2048 x 1536 pixels.
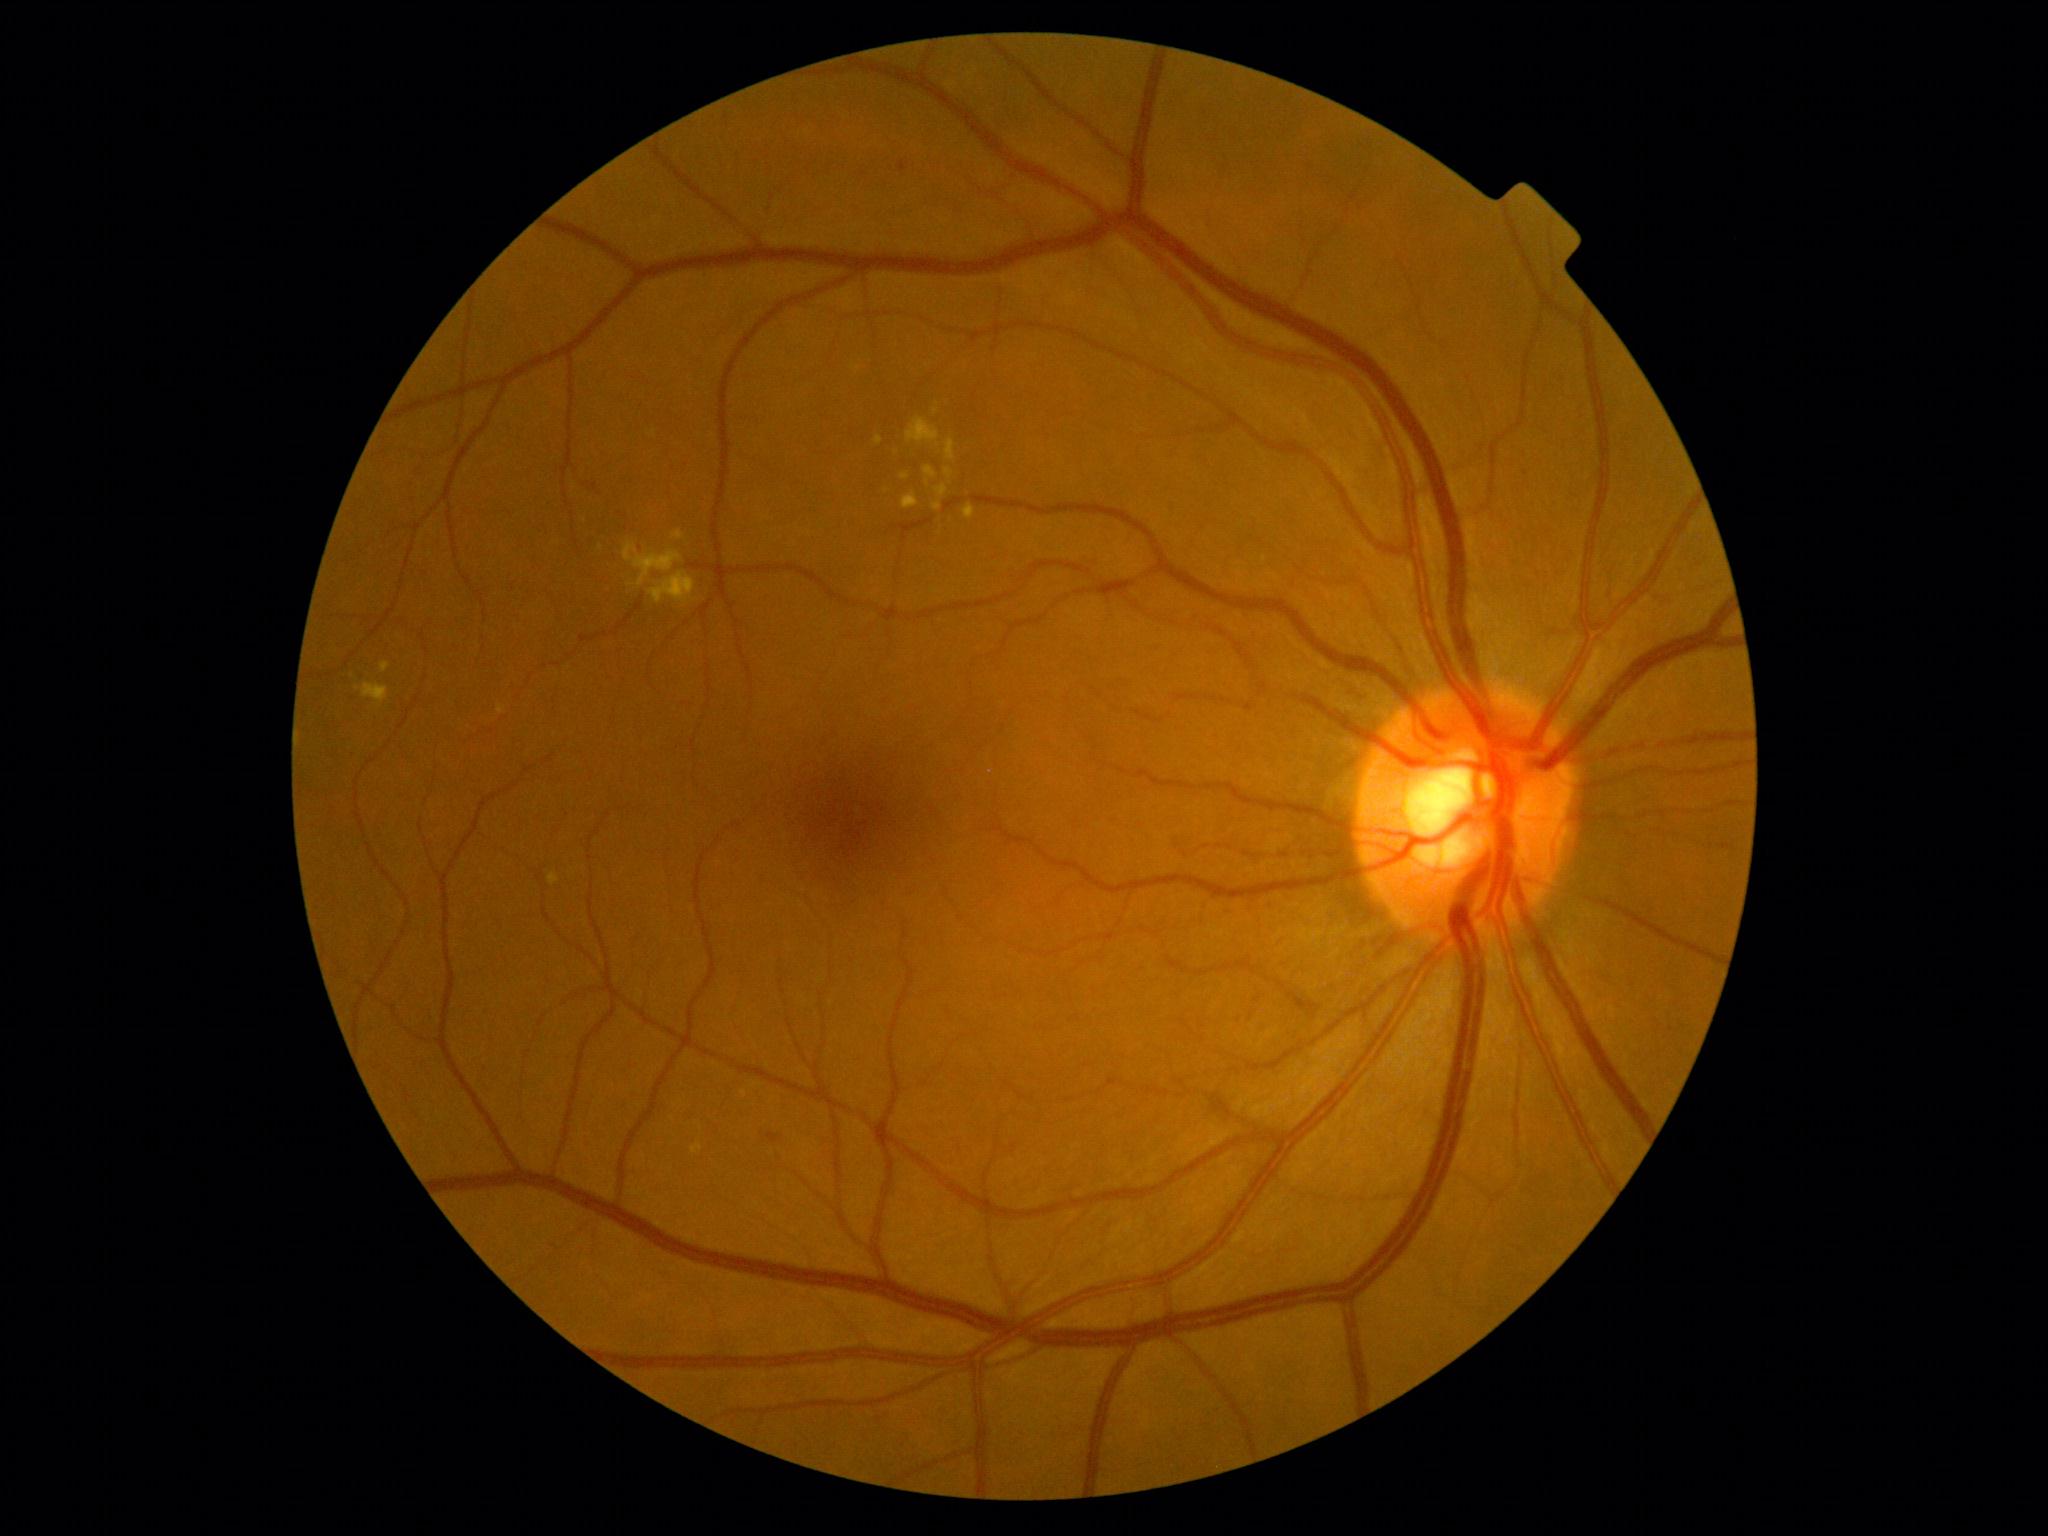

Diabetic retinopathy (DR) is moderate NPDR (grade 2) — more than just microaneurysms but less than severe NPDR. Hard exudates (EXs) are present, including at rect(900, 474, 910, 480), rect(902, 494, 919, 510), rect(356, 683, 389, 706), rect(380, 663, 390, 673), rect(648, 571, 696, 604), rect(875, 435, 883, 445), rect(548, 873, 559, 885), rect(963, 504, 975, 520), rect(945, 468, 953, 480). Additional small EXs near (937,445), (886,491).